Infant wide-field fundus photograph. 1440 x 1080 pixels.
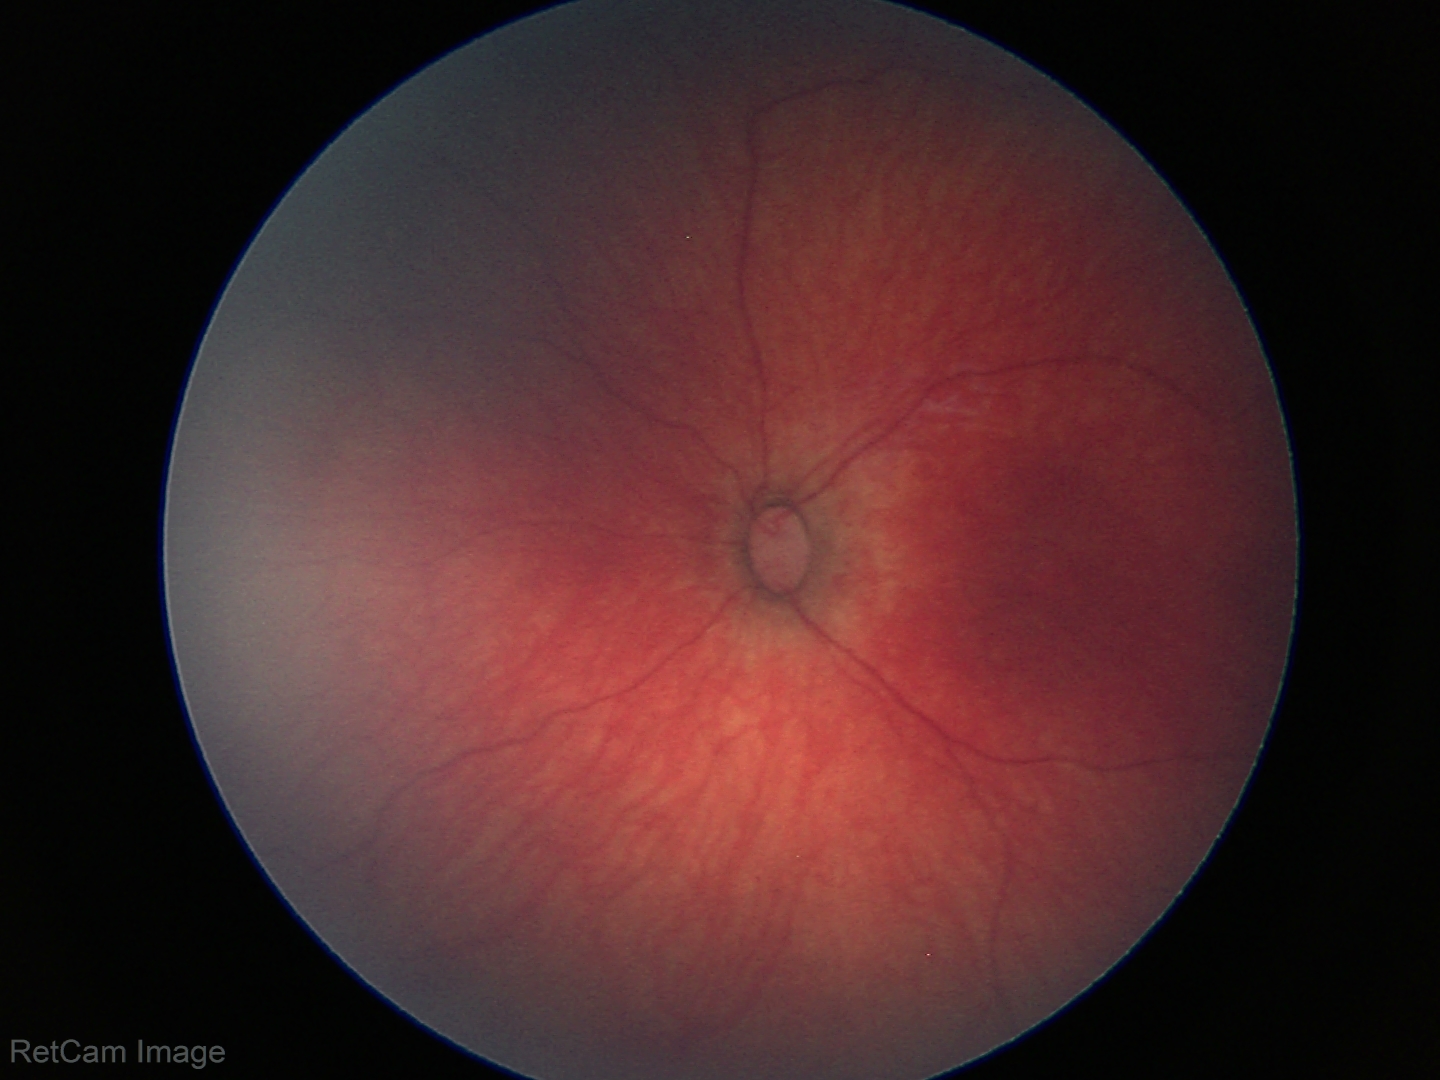 Screening examination with no abnormal retinal findings.